Wide-field fundus photograph from neonatal ROP screening.
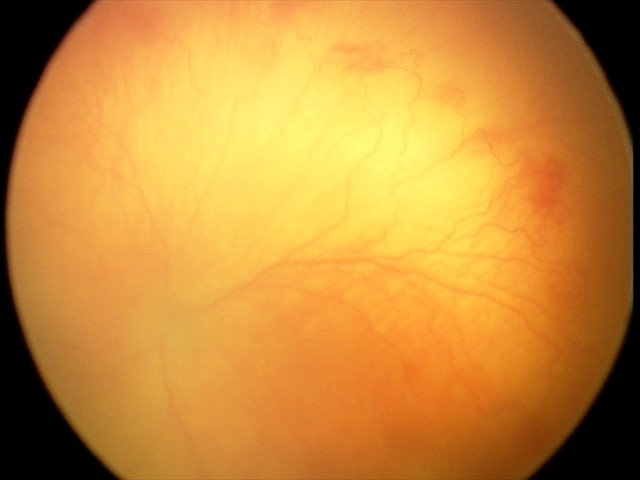

From an examination with diagnosis of A-ROP (aggressive ROP).
With plus disease.